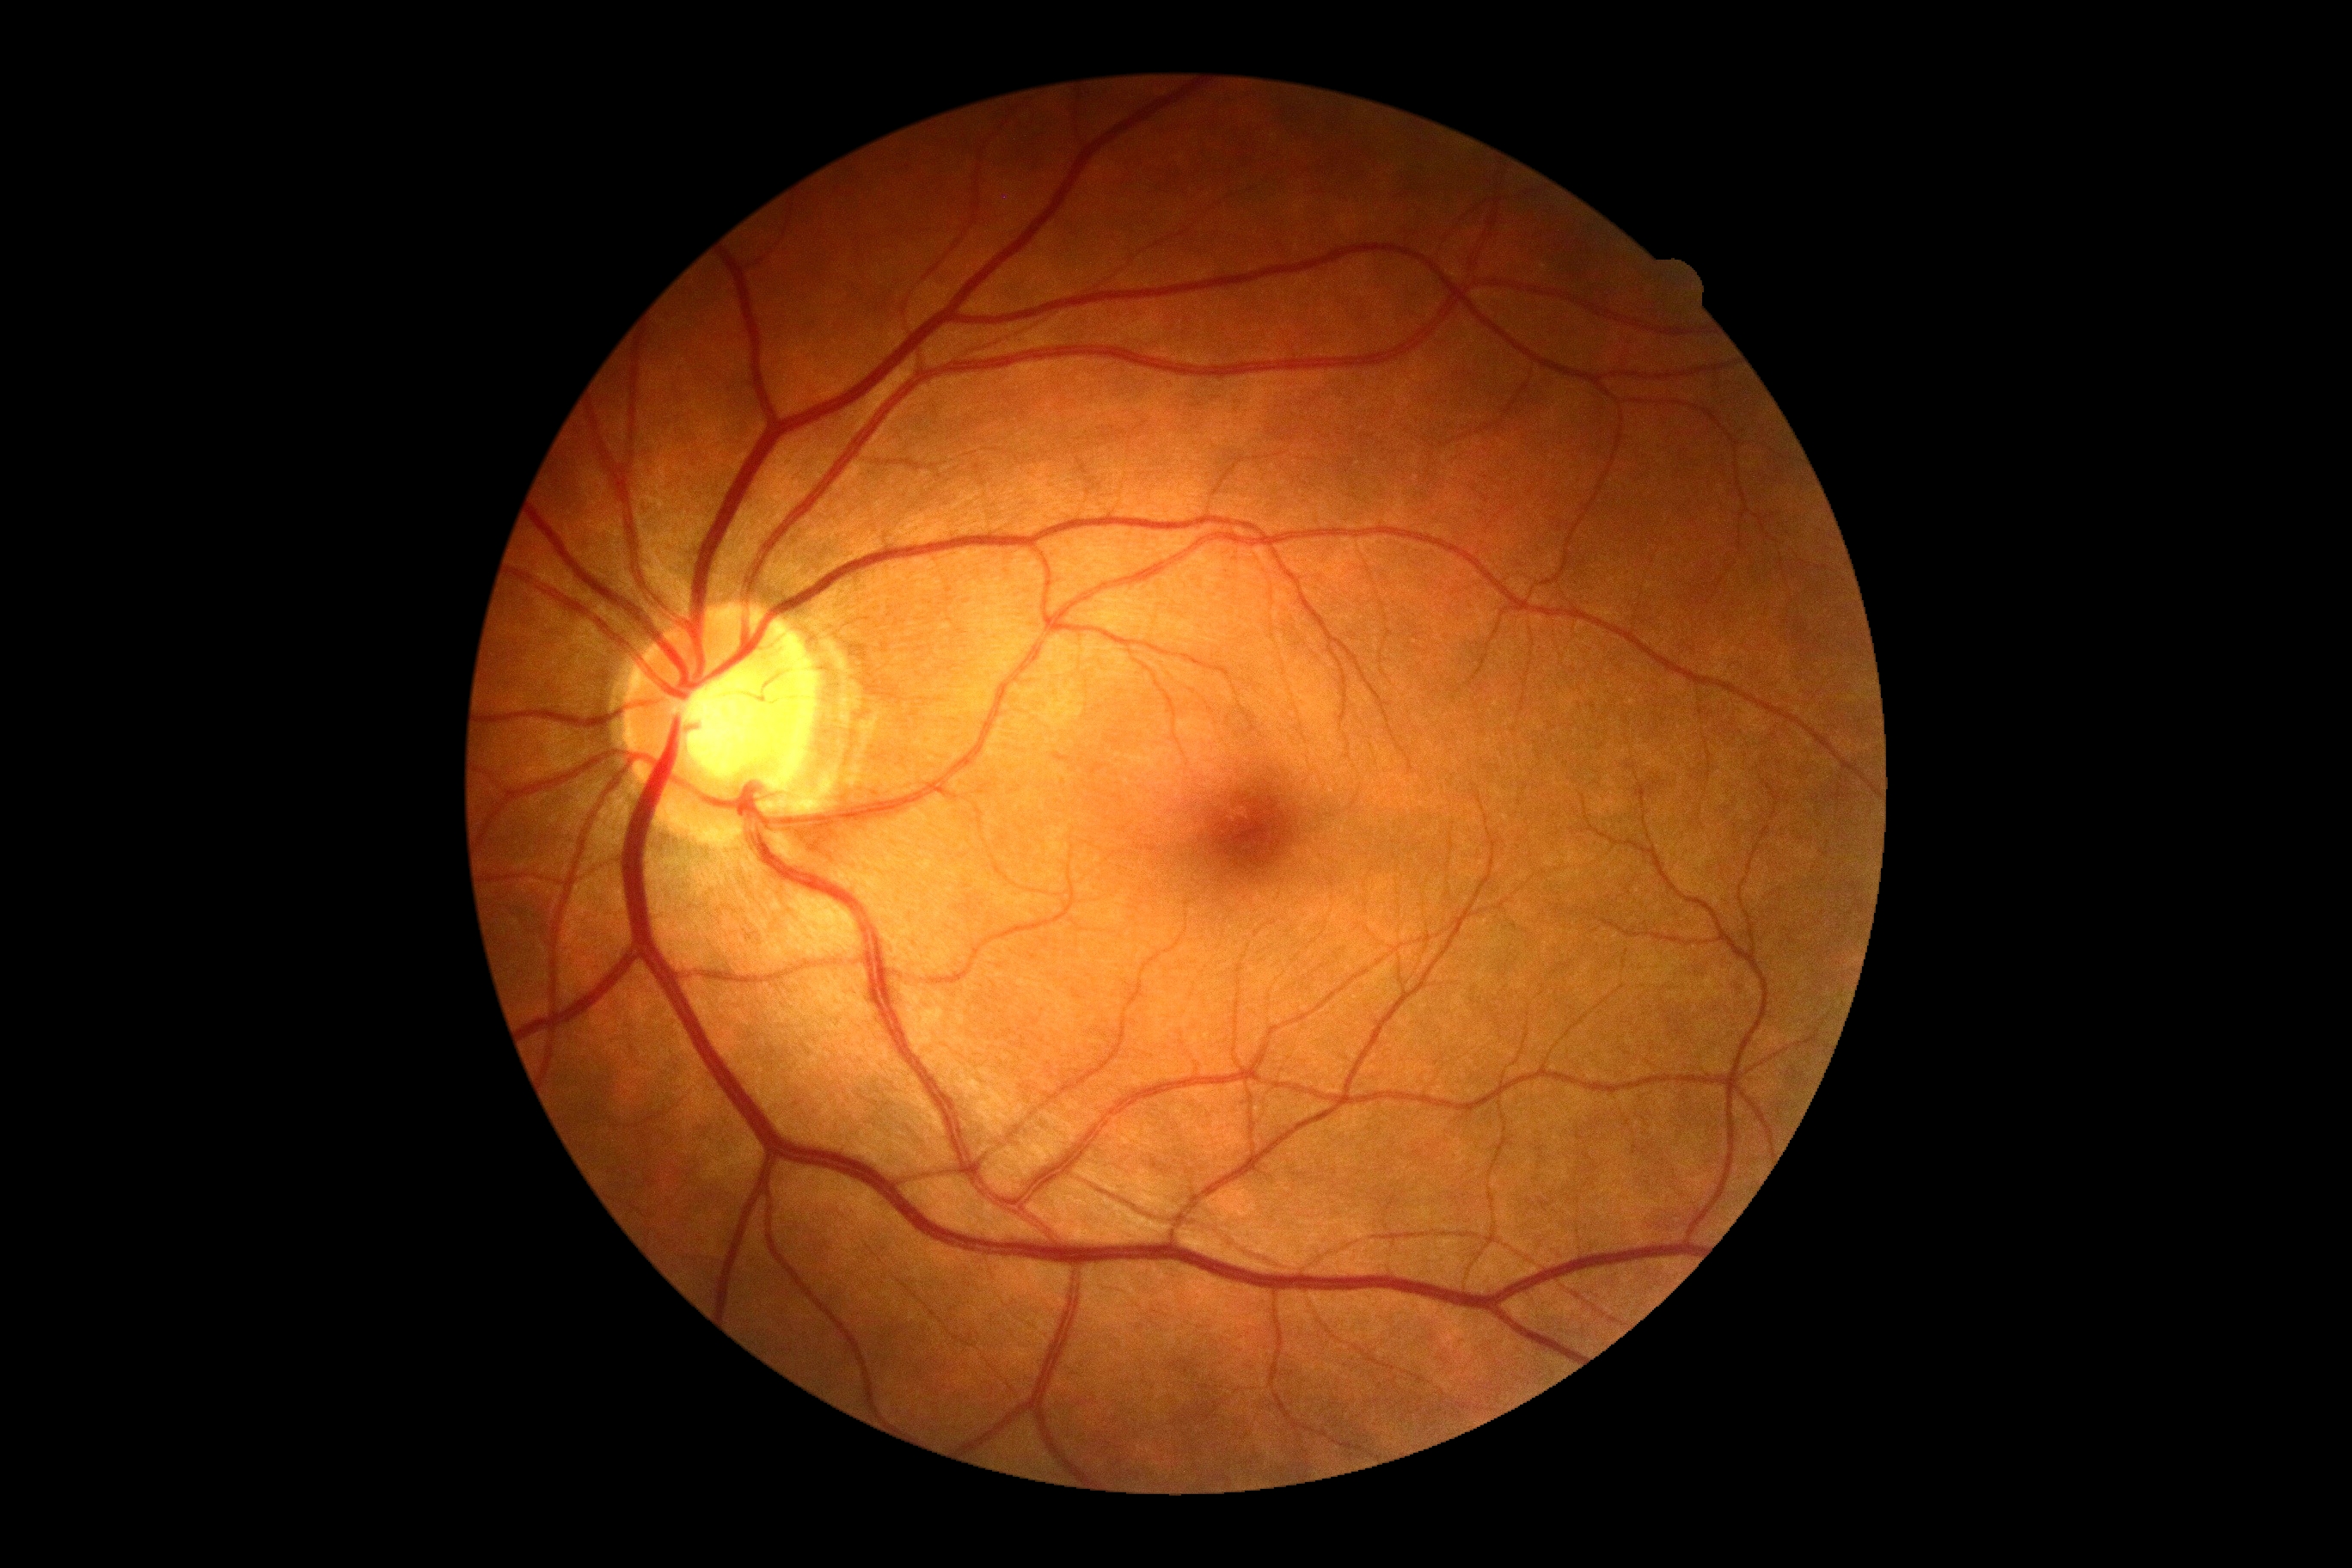
DR: no apparent retinopathy (grade 0) — no visible signs of diabetic retinopathy.